Retinal fundus photograph — 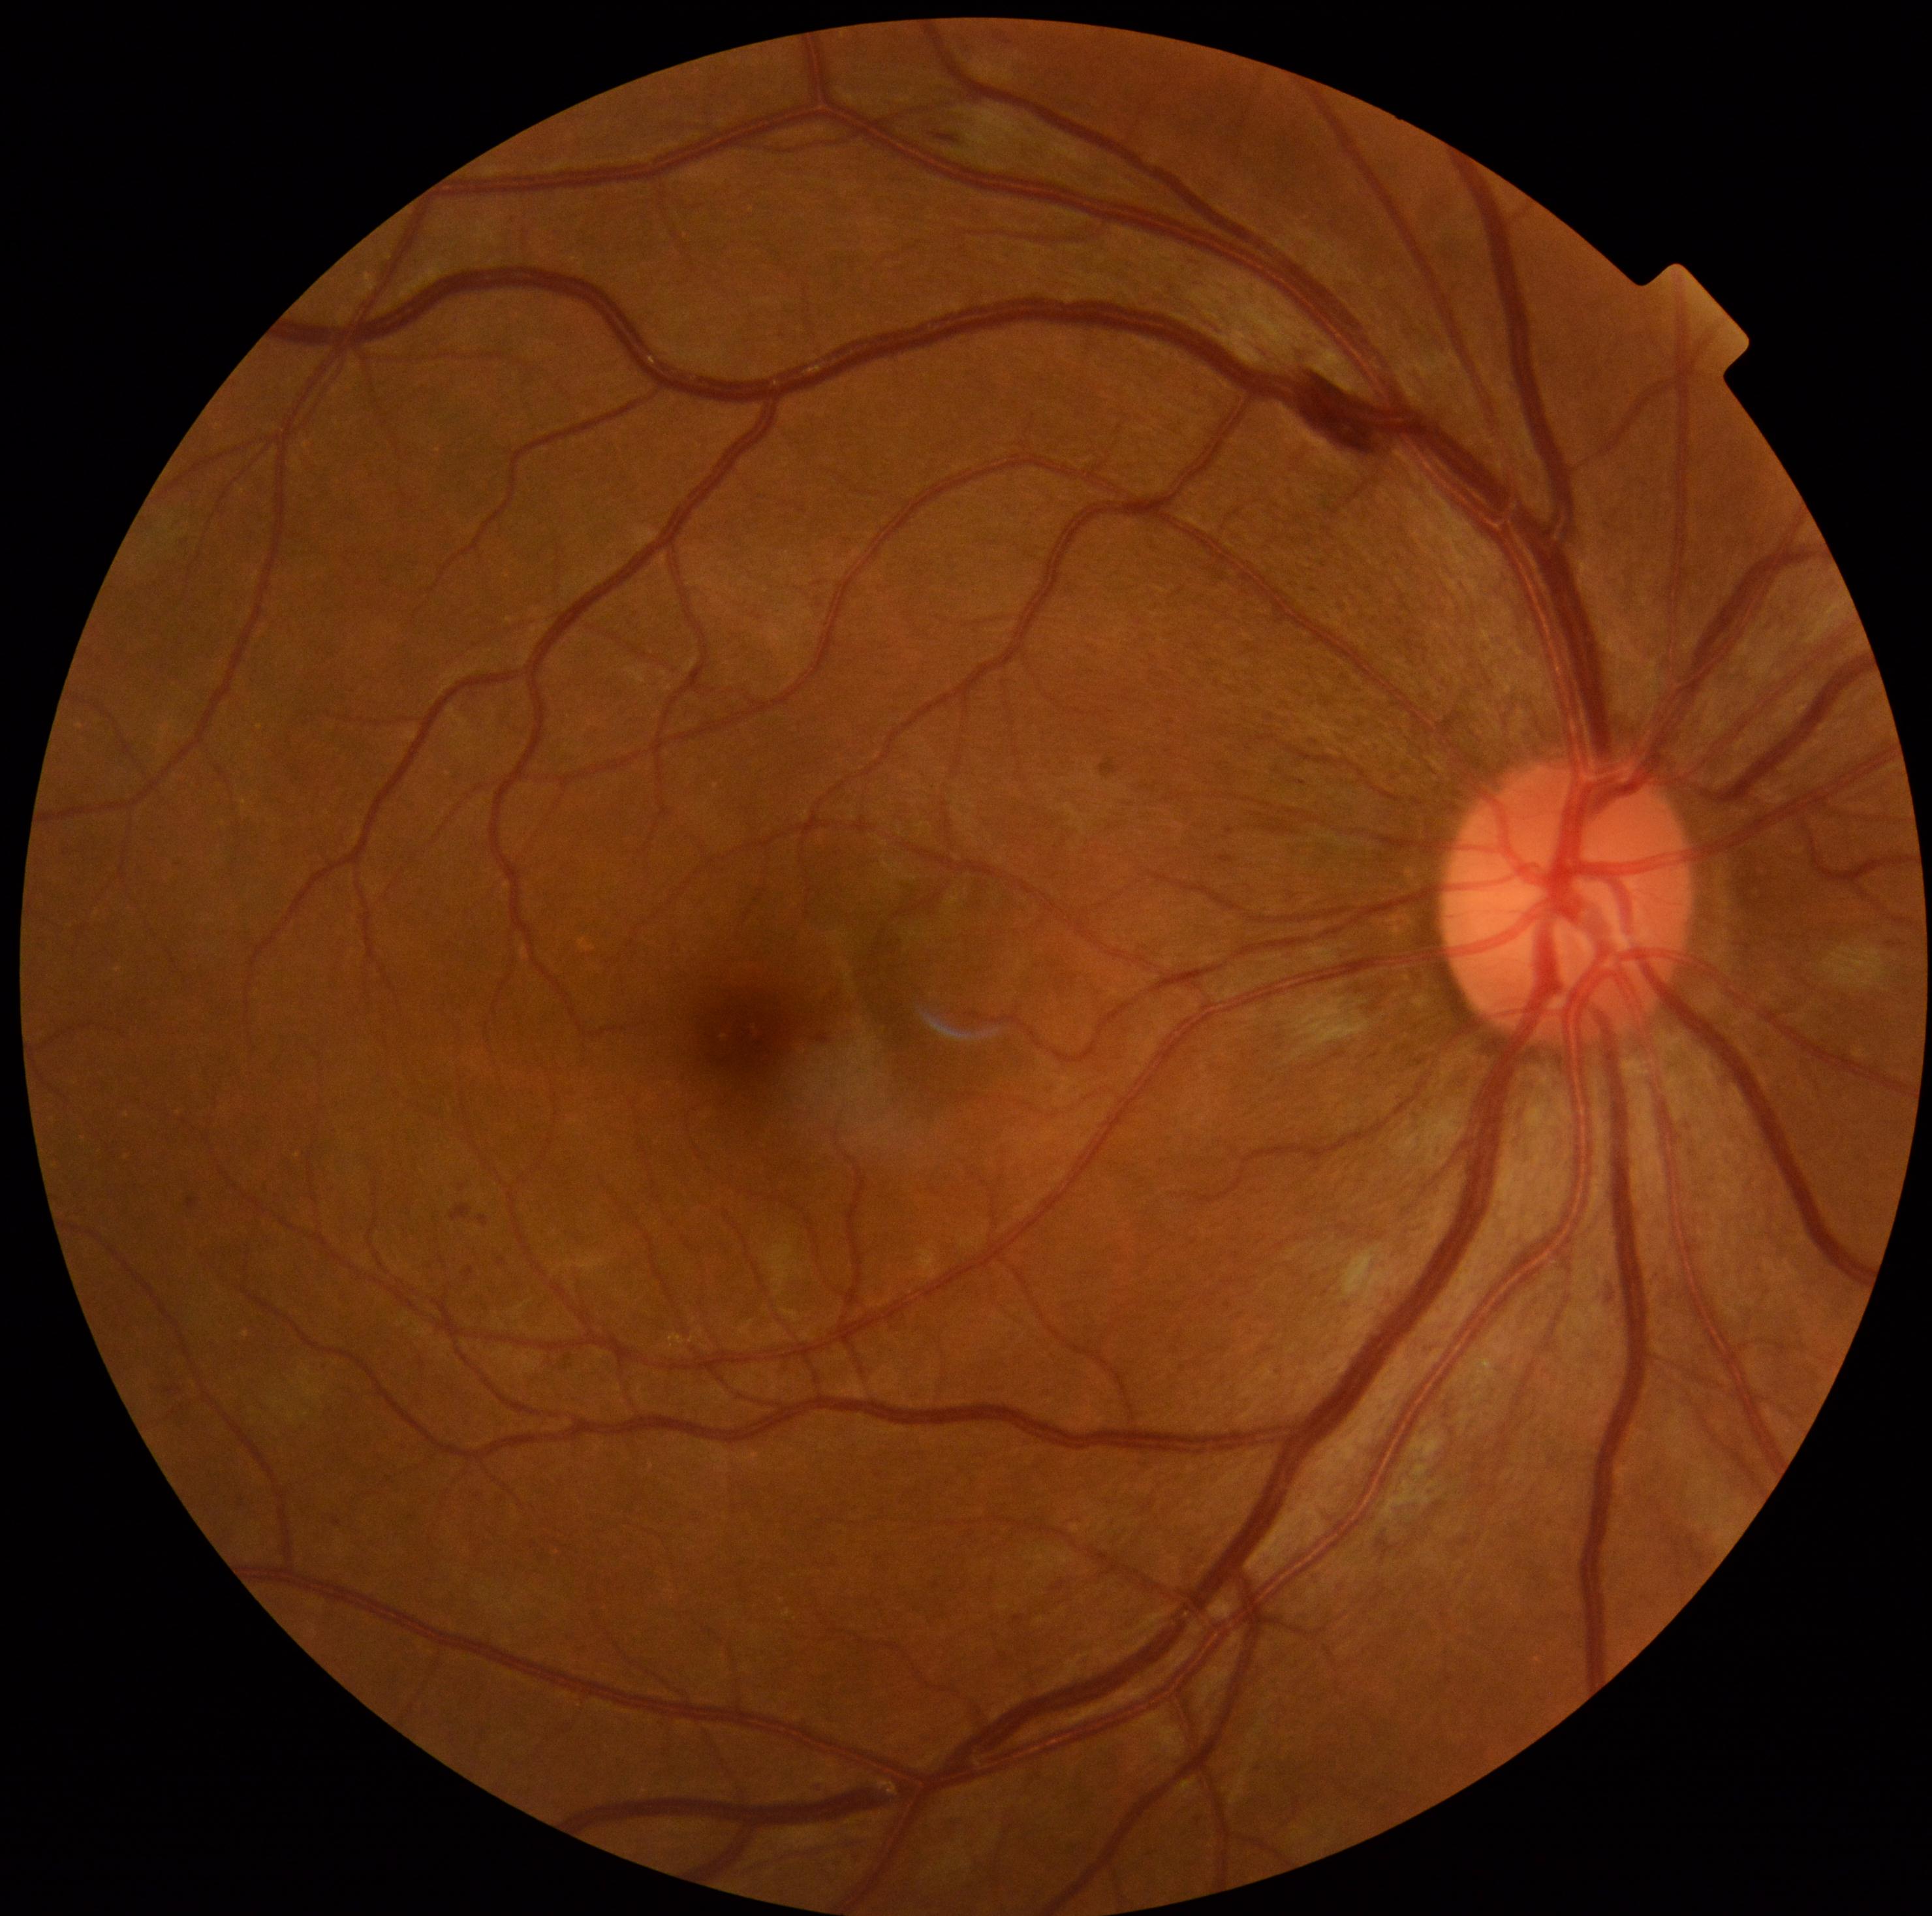
Diabetic retinopathy (DR): moderate non-proliferative diabetic retinopathy (grade 2) — more than just microaneurysms but less than severe NPDR.